Fundus image cropped to the optic disc
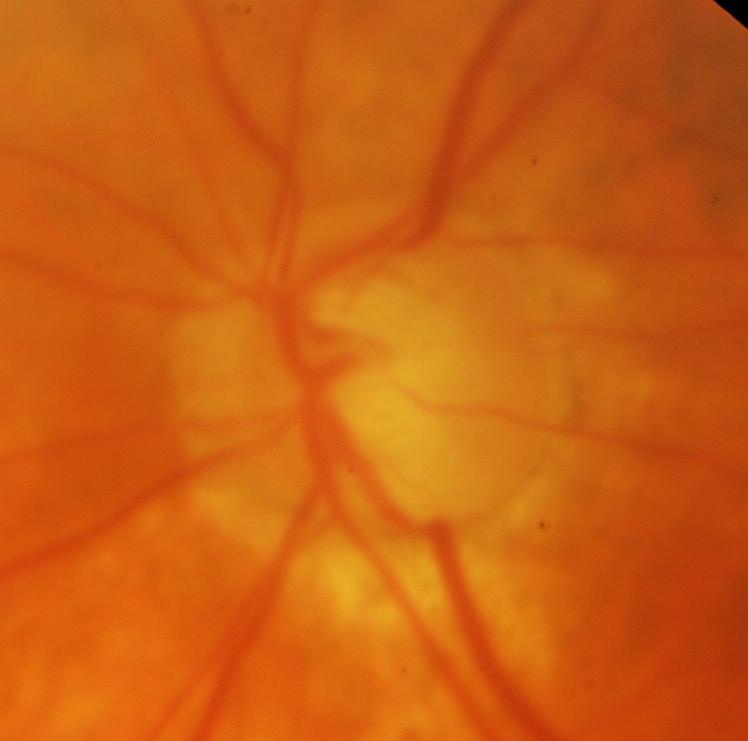

Finding: glaucoma.